2089x1764.
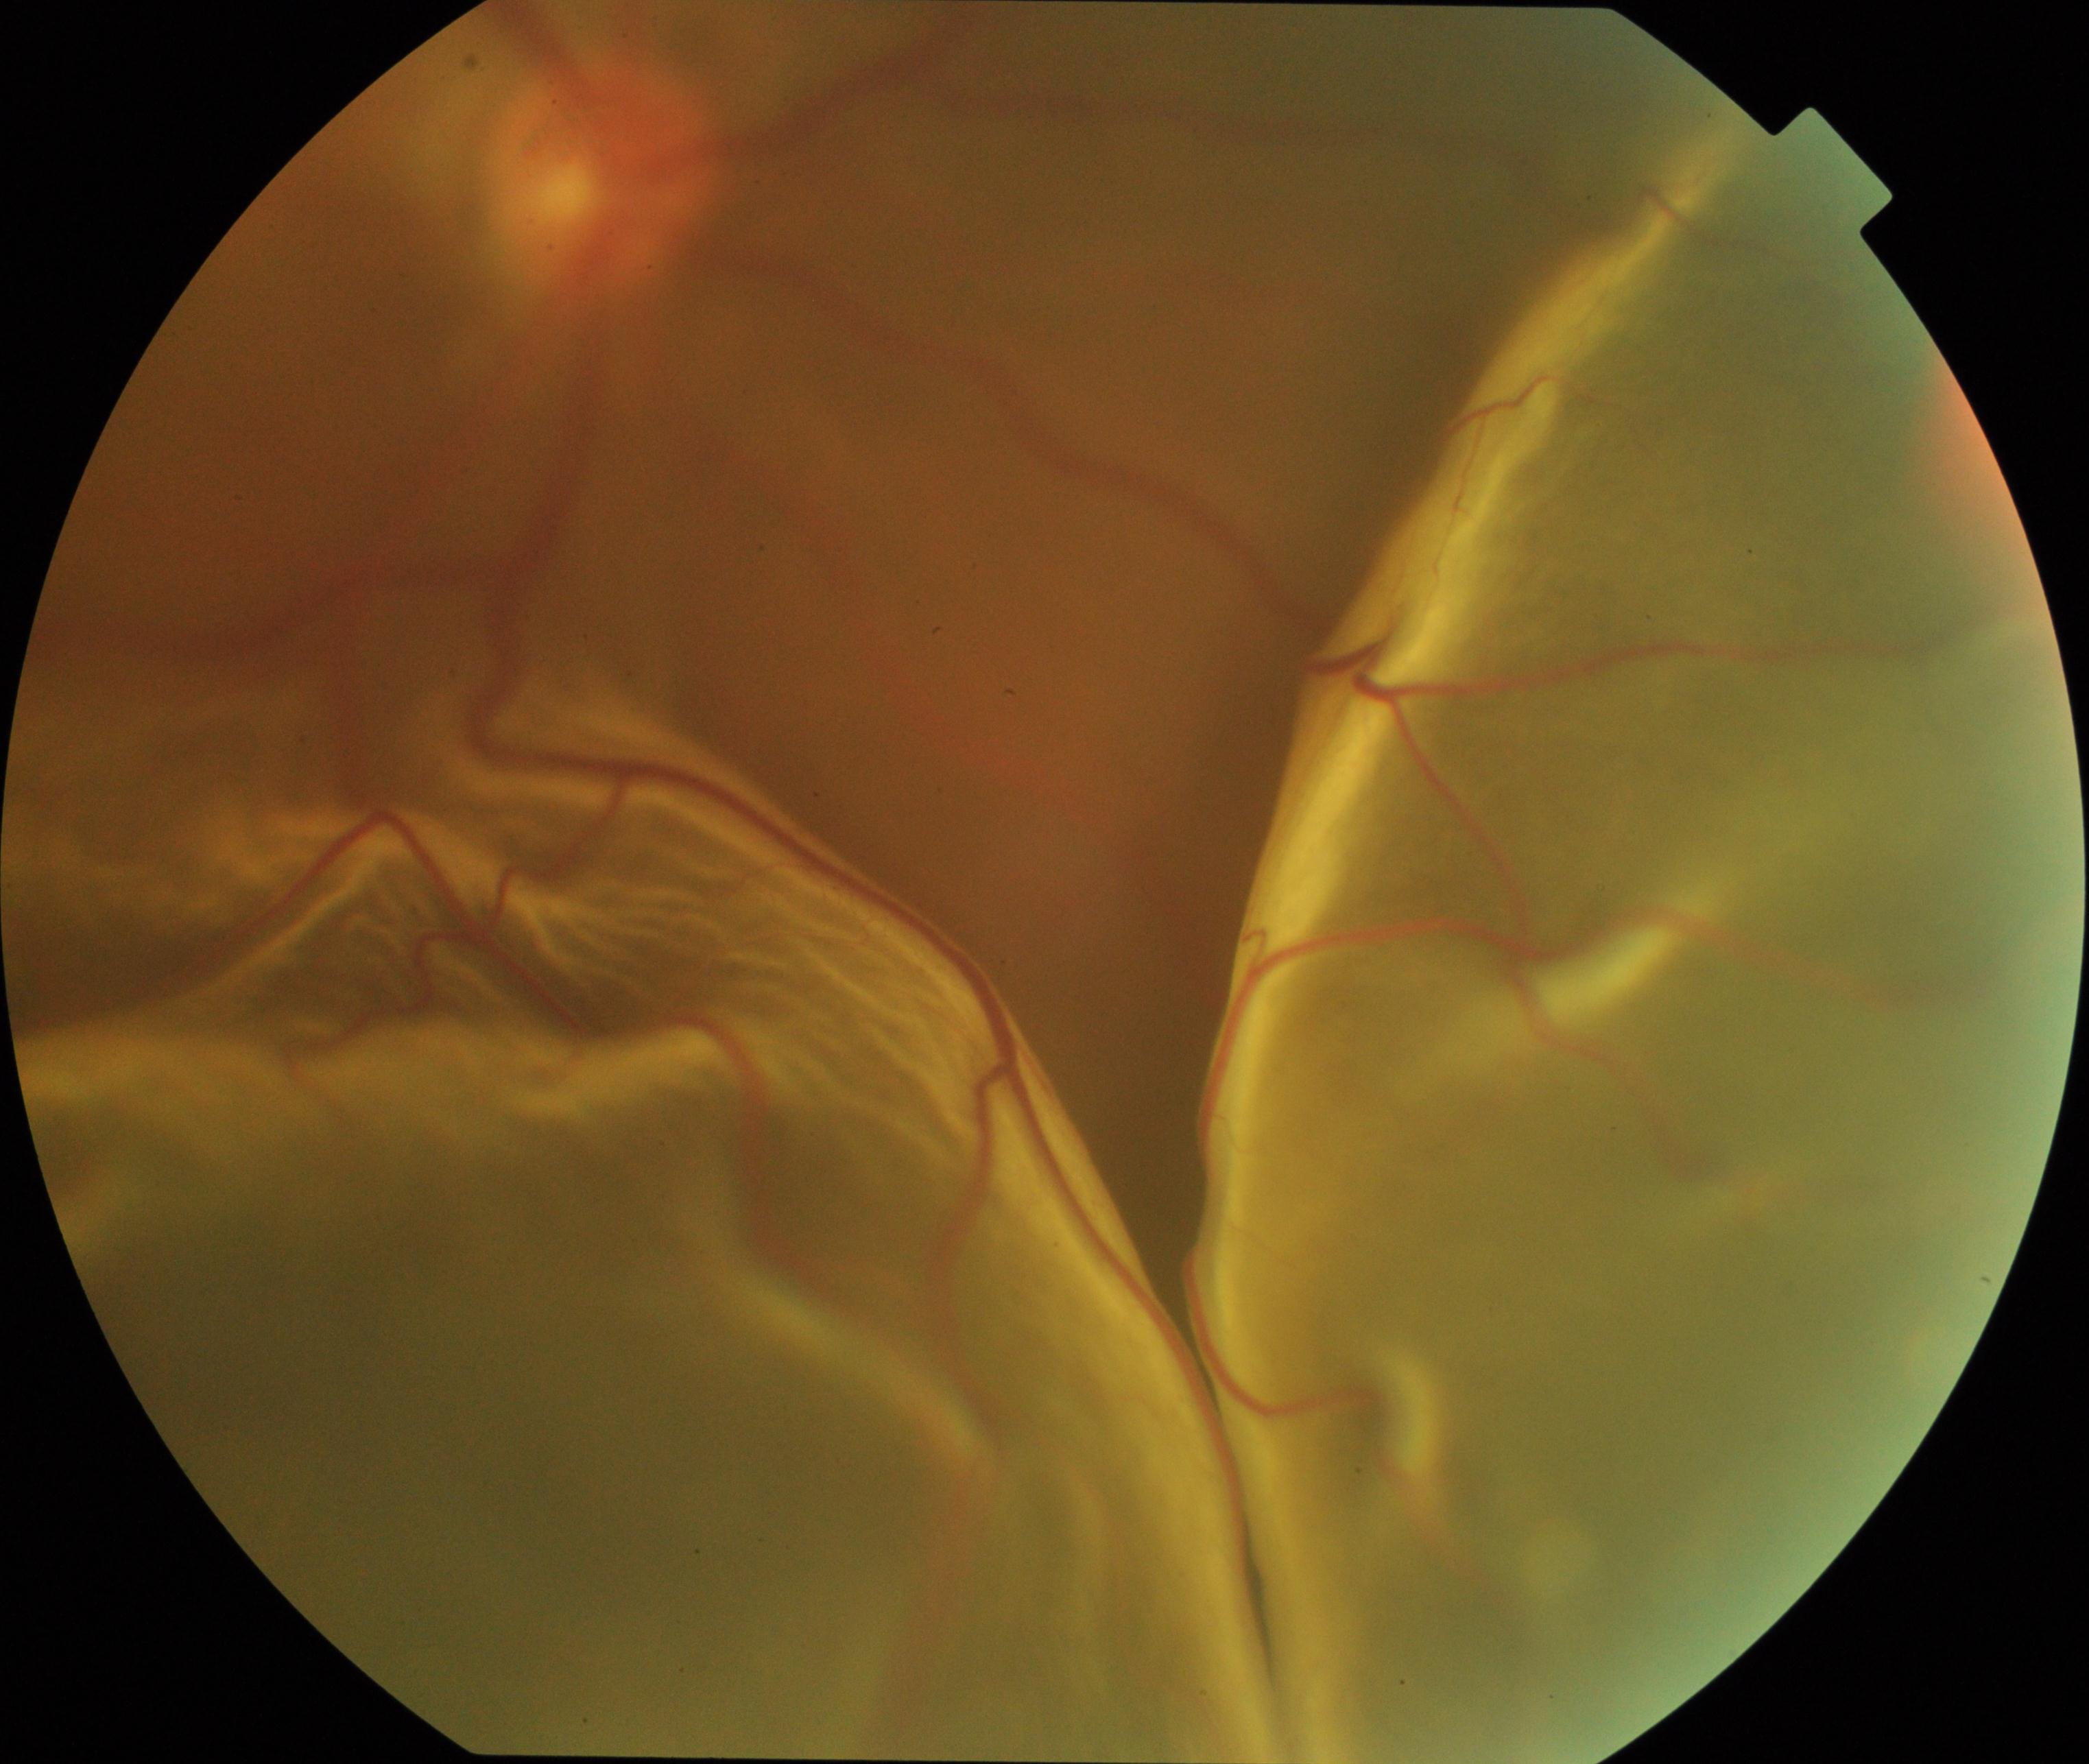

The image shows rhegmatogenous retinal detachment.